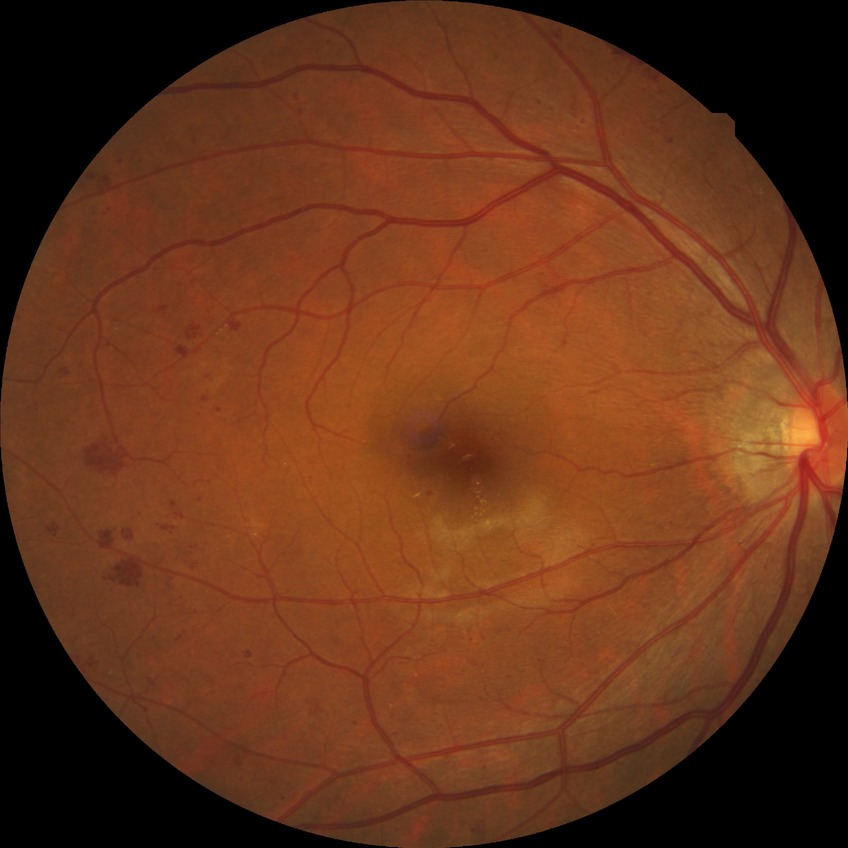 Retinopathy stage: simple diabetic retinopathy.